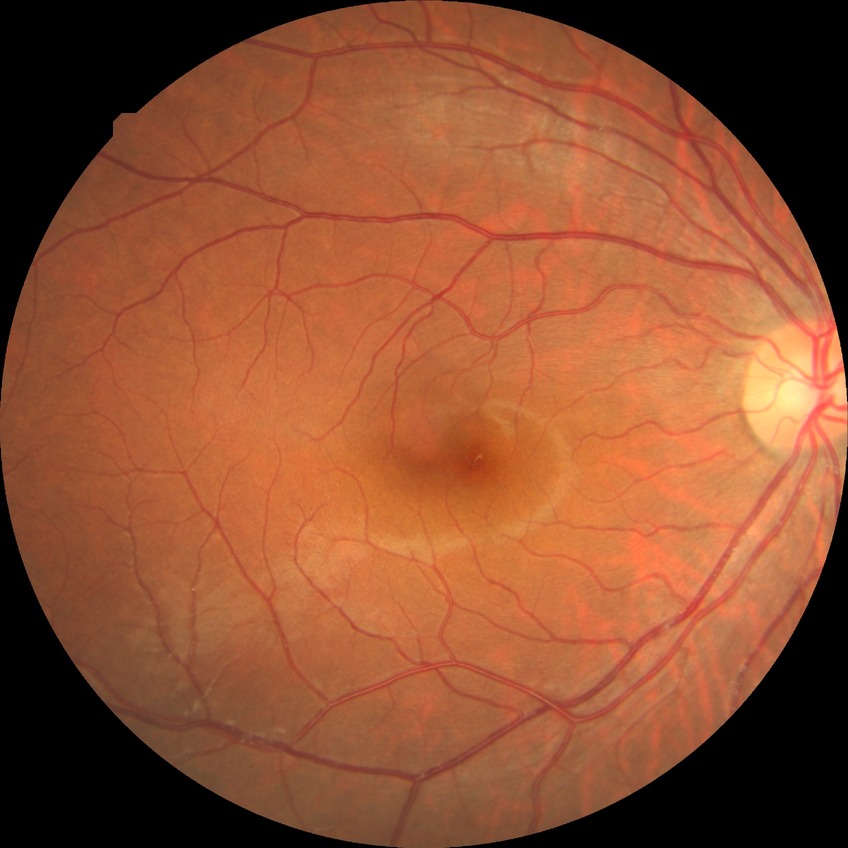 DR stage is NDR.